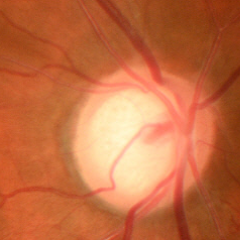 Findings consistent with glaucoma. Impression = early-stage glaucoma. Diagnostic criteria: glaucomatous retinal nerve fiber layer defects on red-free fundus photography without visual field defects.